45° FOV · 1932 x 1932 pixels: 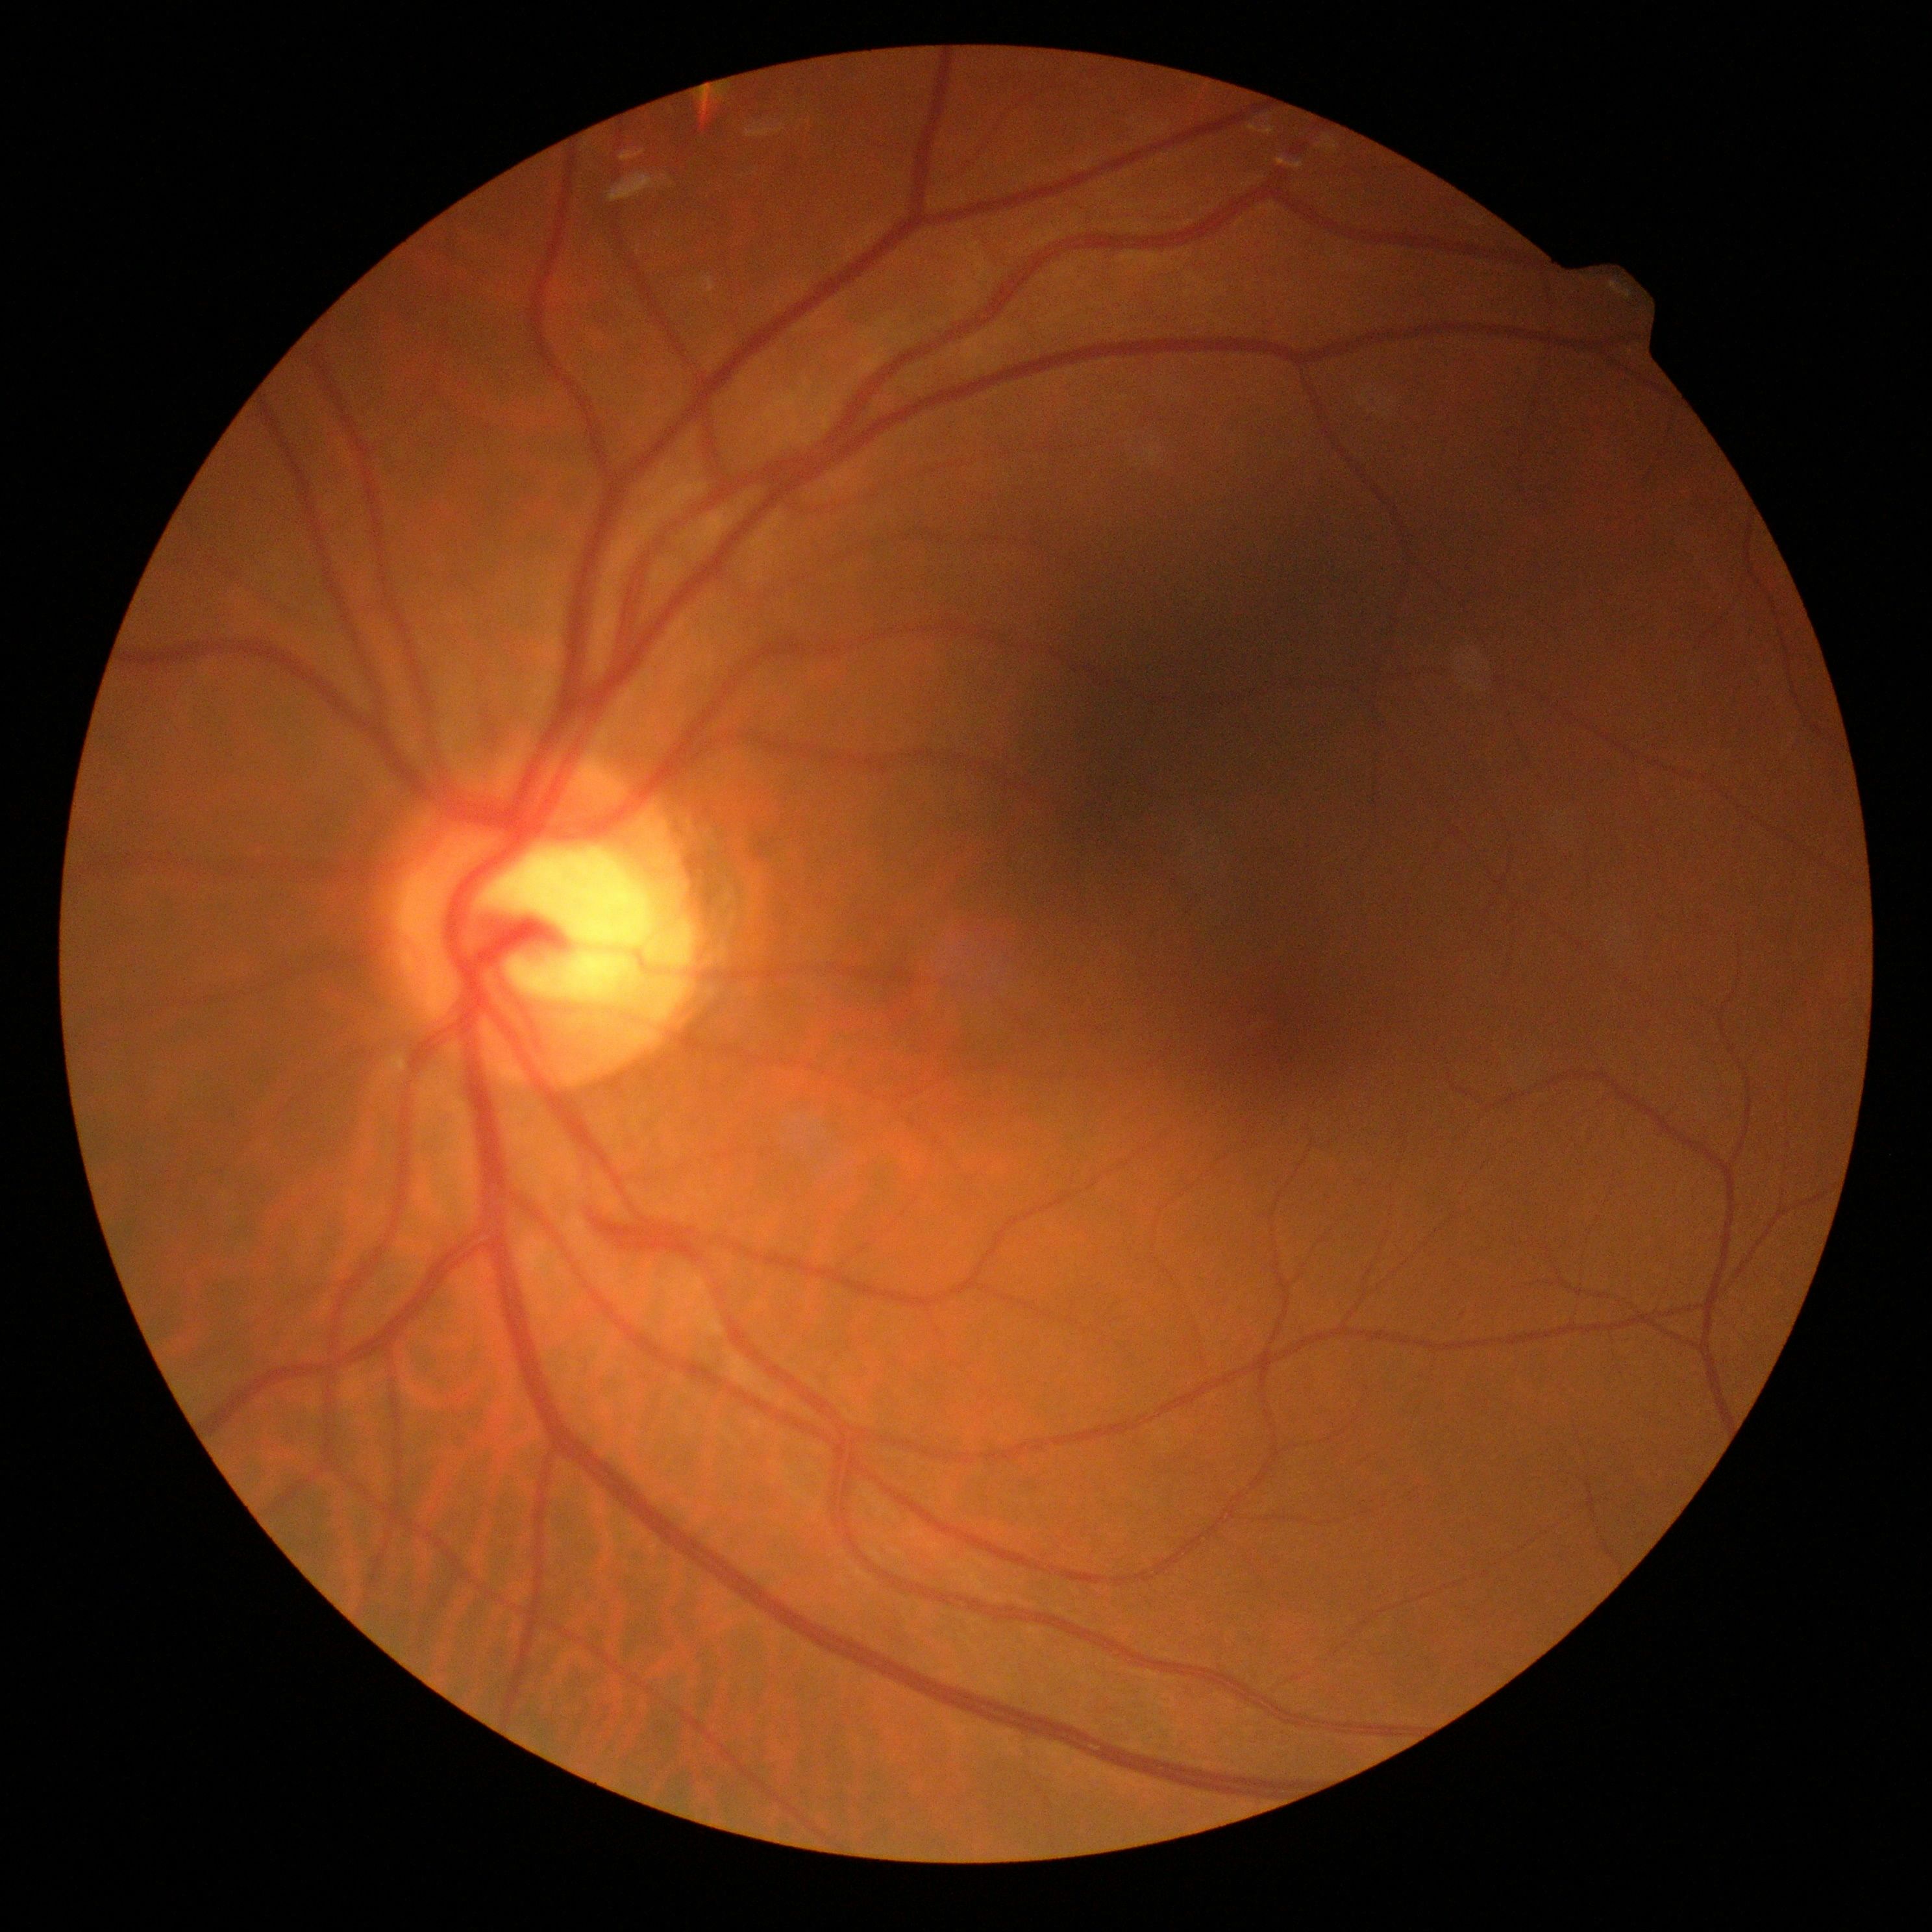

No apparent diabetic retinopathy. DR is 0.